Ultra-widefield fundus photograph
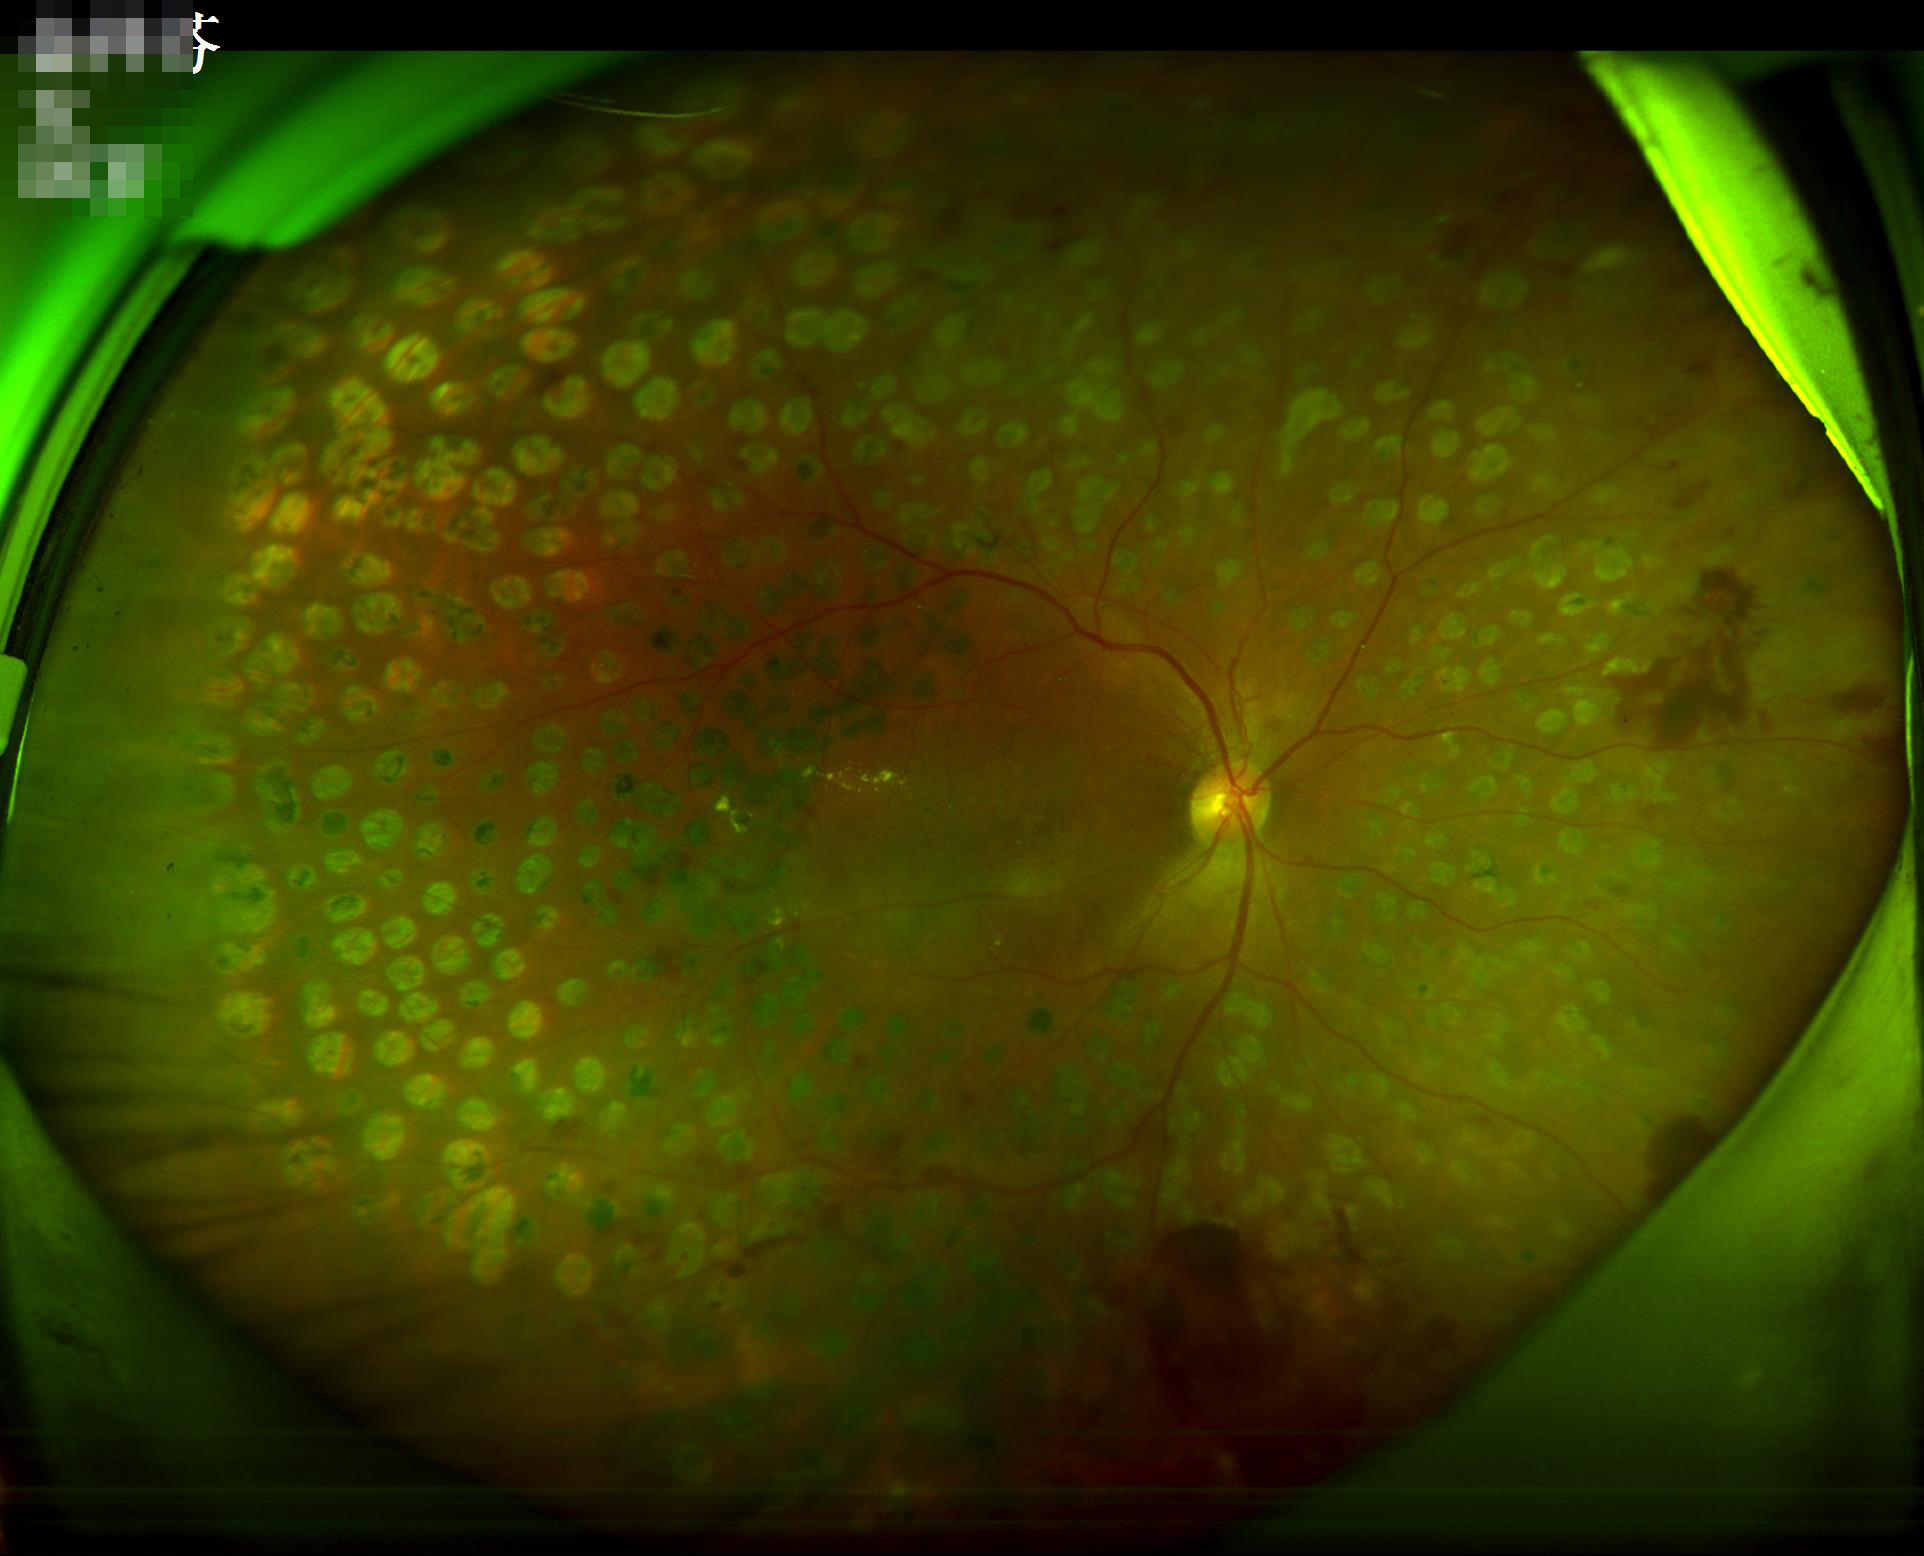 clarity: clear
contrast: satisfactory
overall_quality: acceptable